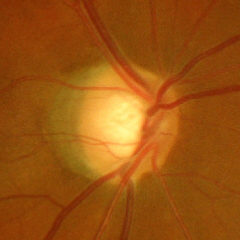 Showing severe glaucomatous damage.